Modified Davis classification: 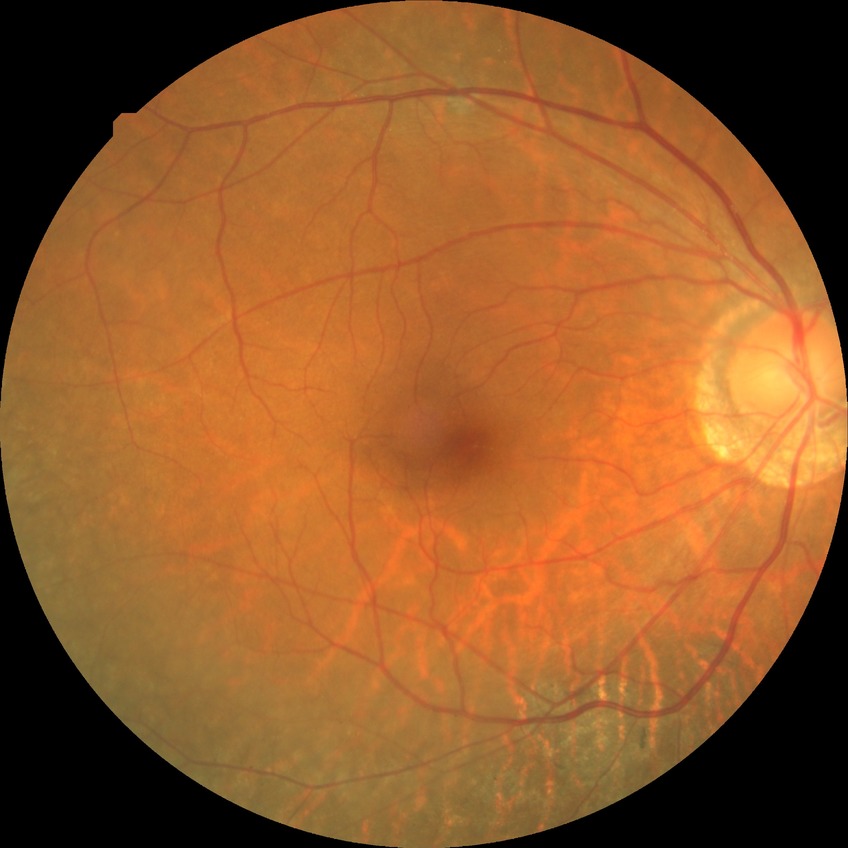
Diabetic retinopathy (DR): no diabetic retinopathy (NDR).